848x848; NIDEK AFC-230:
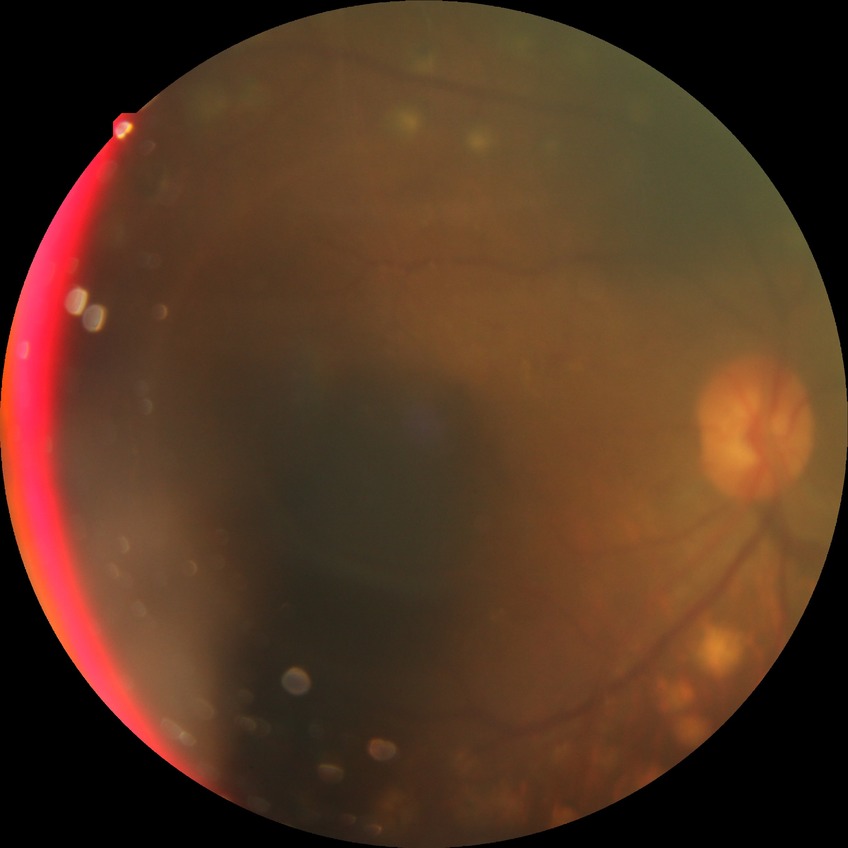 DR grade = PDR.